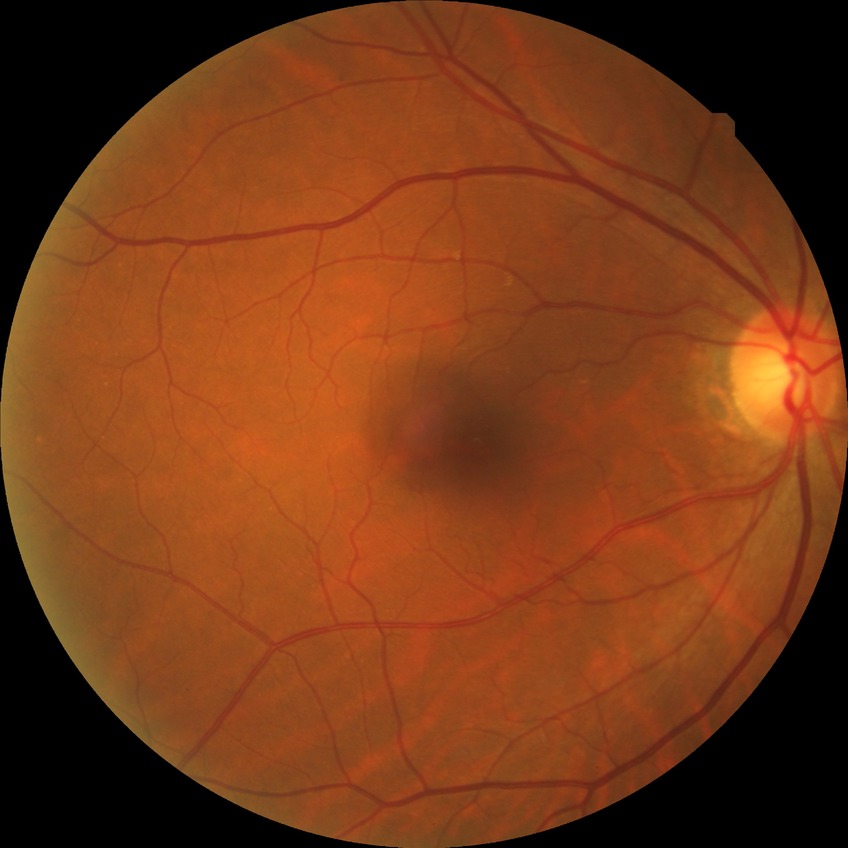
Diabetic retinopathy (DR) is no diabetic retinopathy (NDR).